Posterior pole photograph. Nonmydriatic fundus photograph:
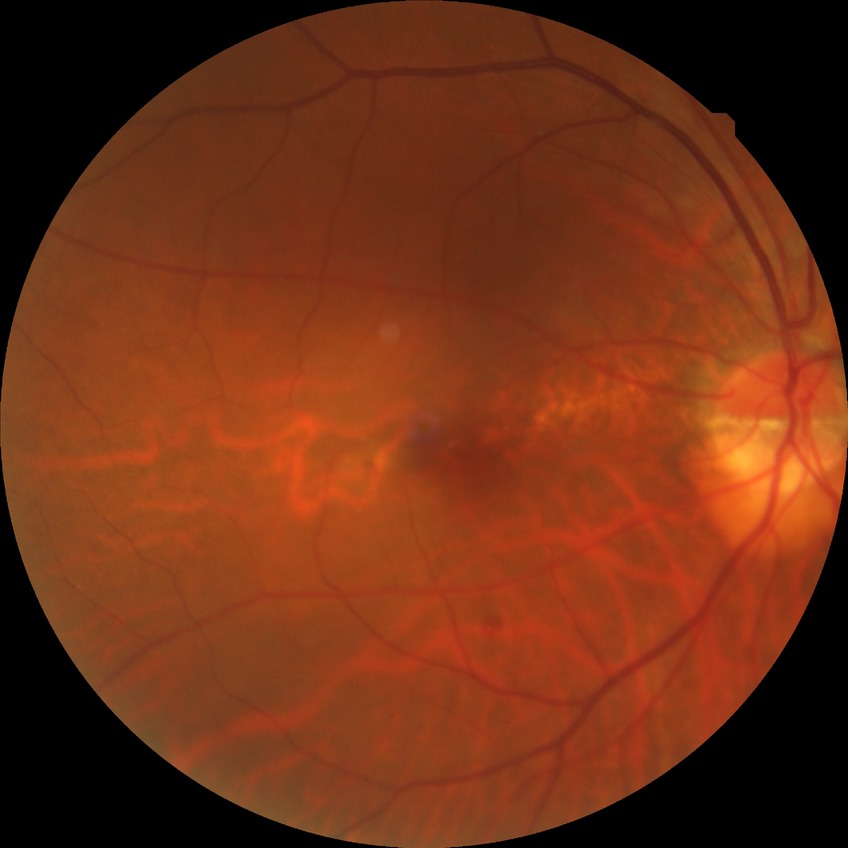 Modified Davis grading: simple diabetic retinopathy.